640 by 480 pixels. 130° field of view (Clarity RetCam 3). Infant wide-field fundus photograph: 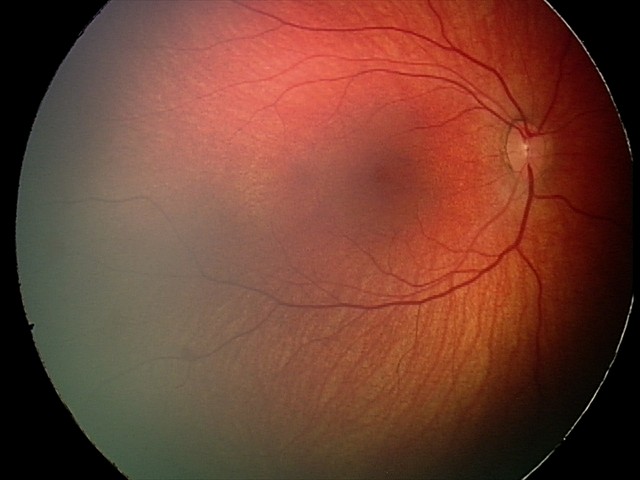
Series diagnosed as retinal hemorrhages.